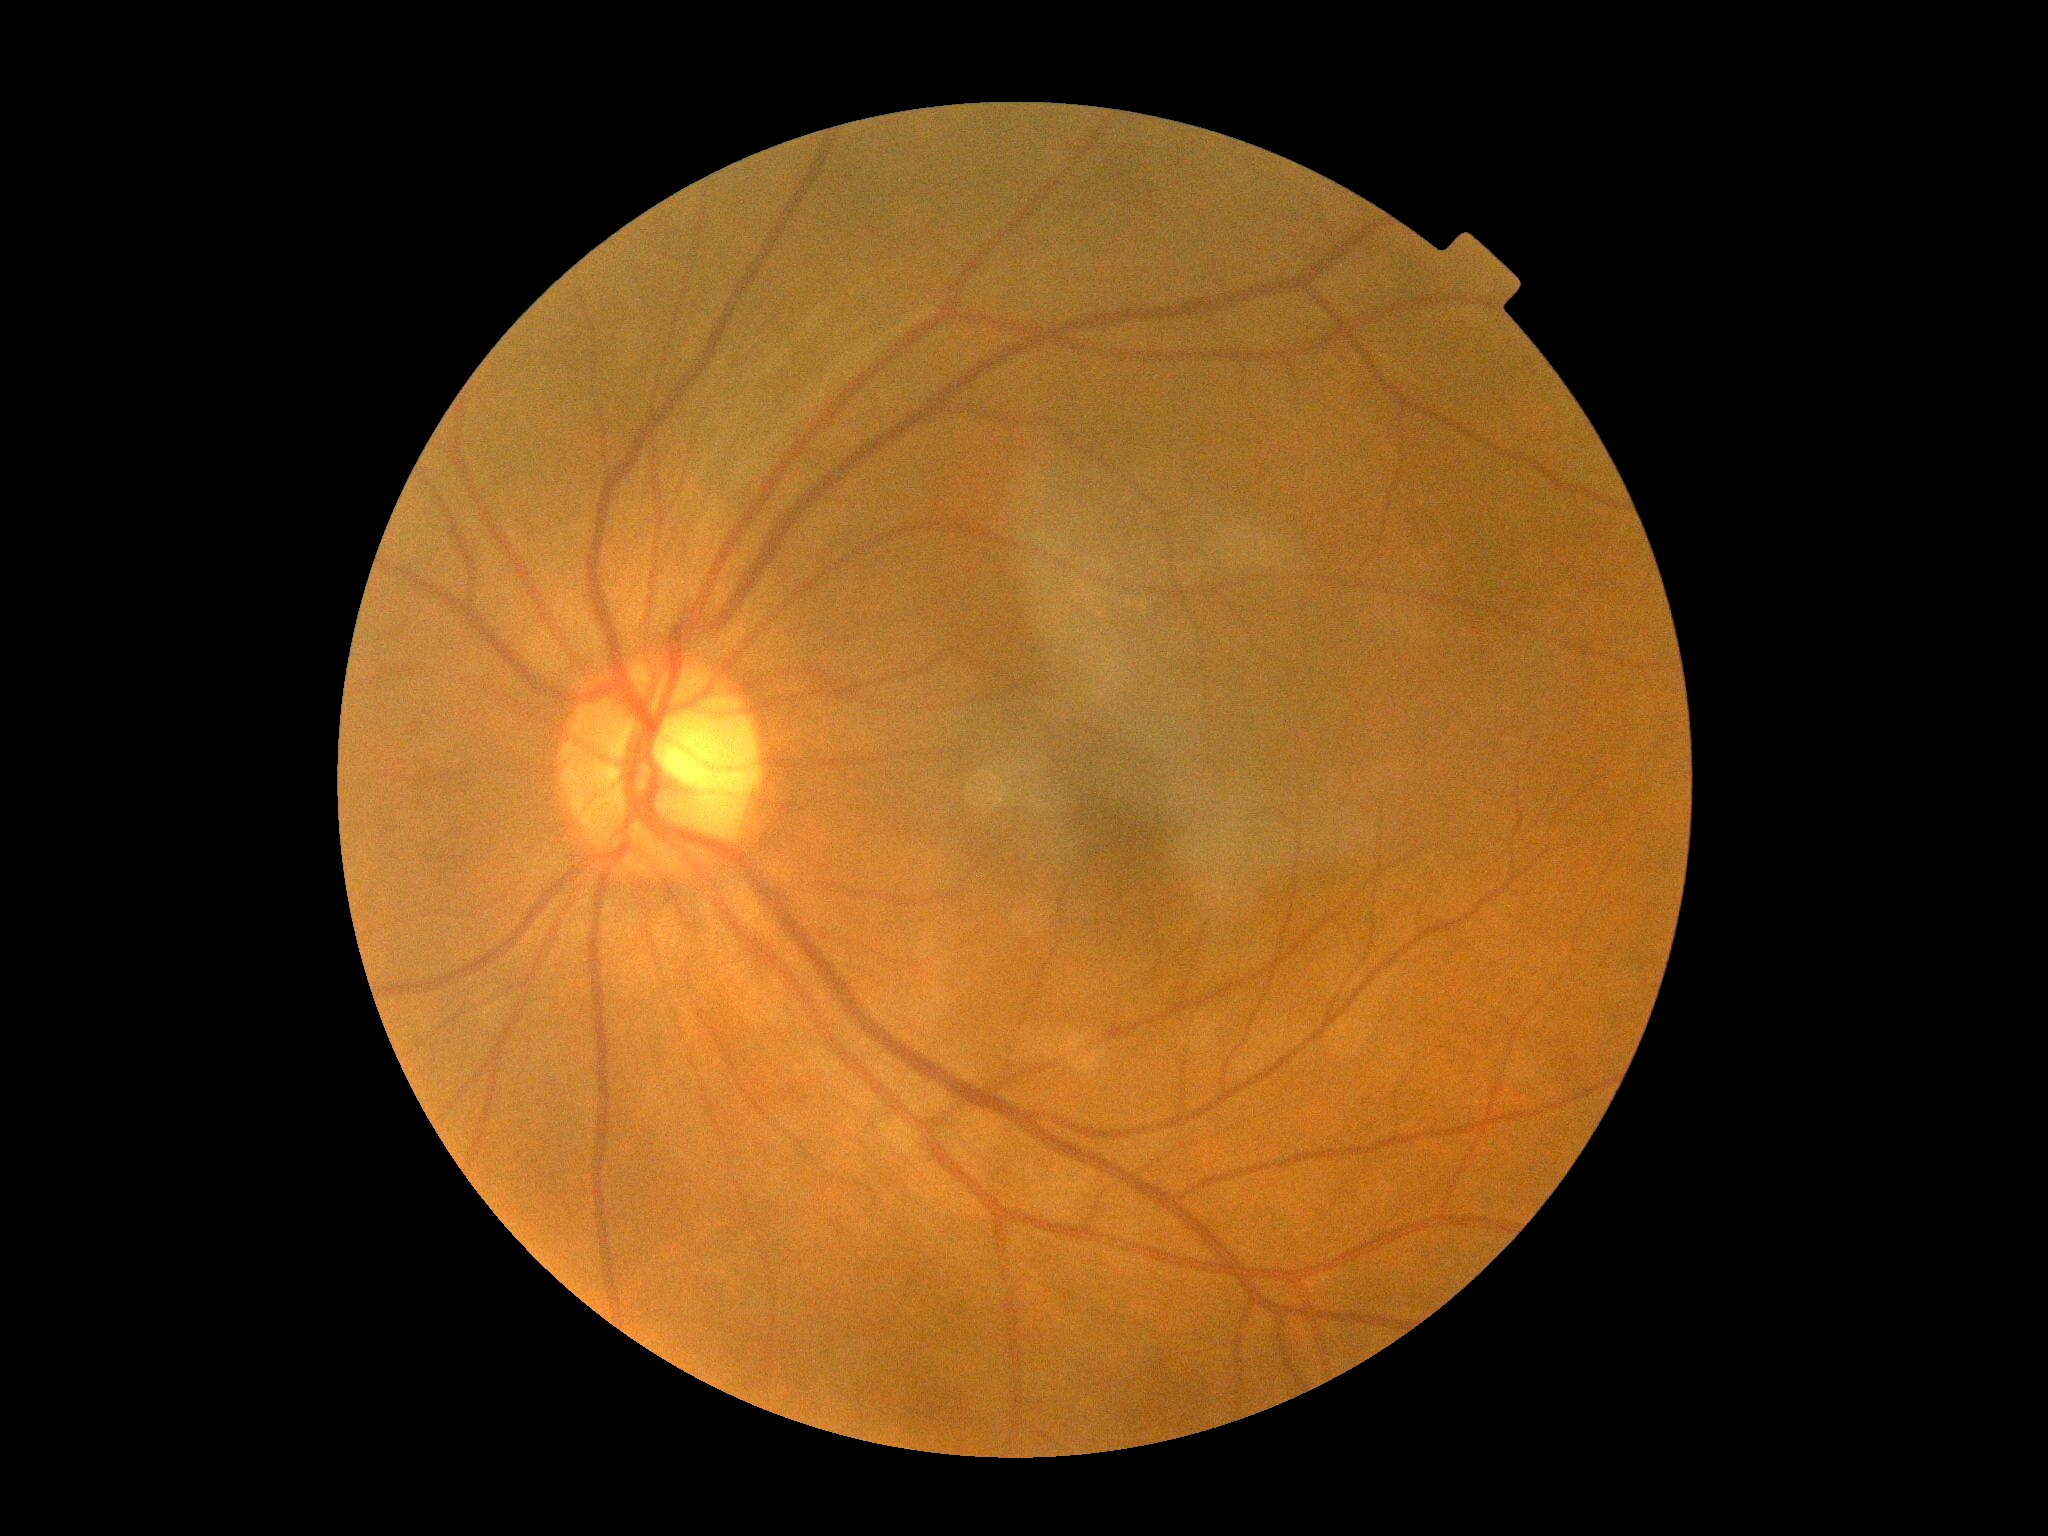 DR impression: no DR findings; diabetic retinopathy grade: 0 (no apparent retinopathy).